45° FOV
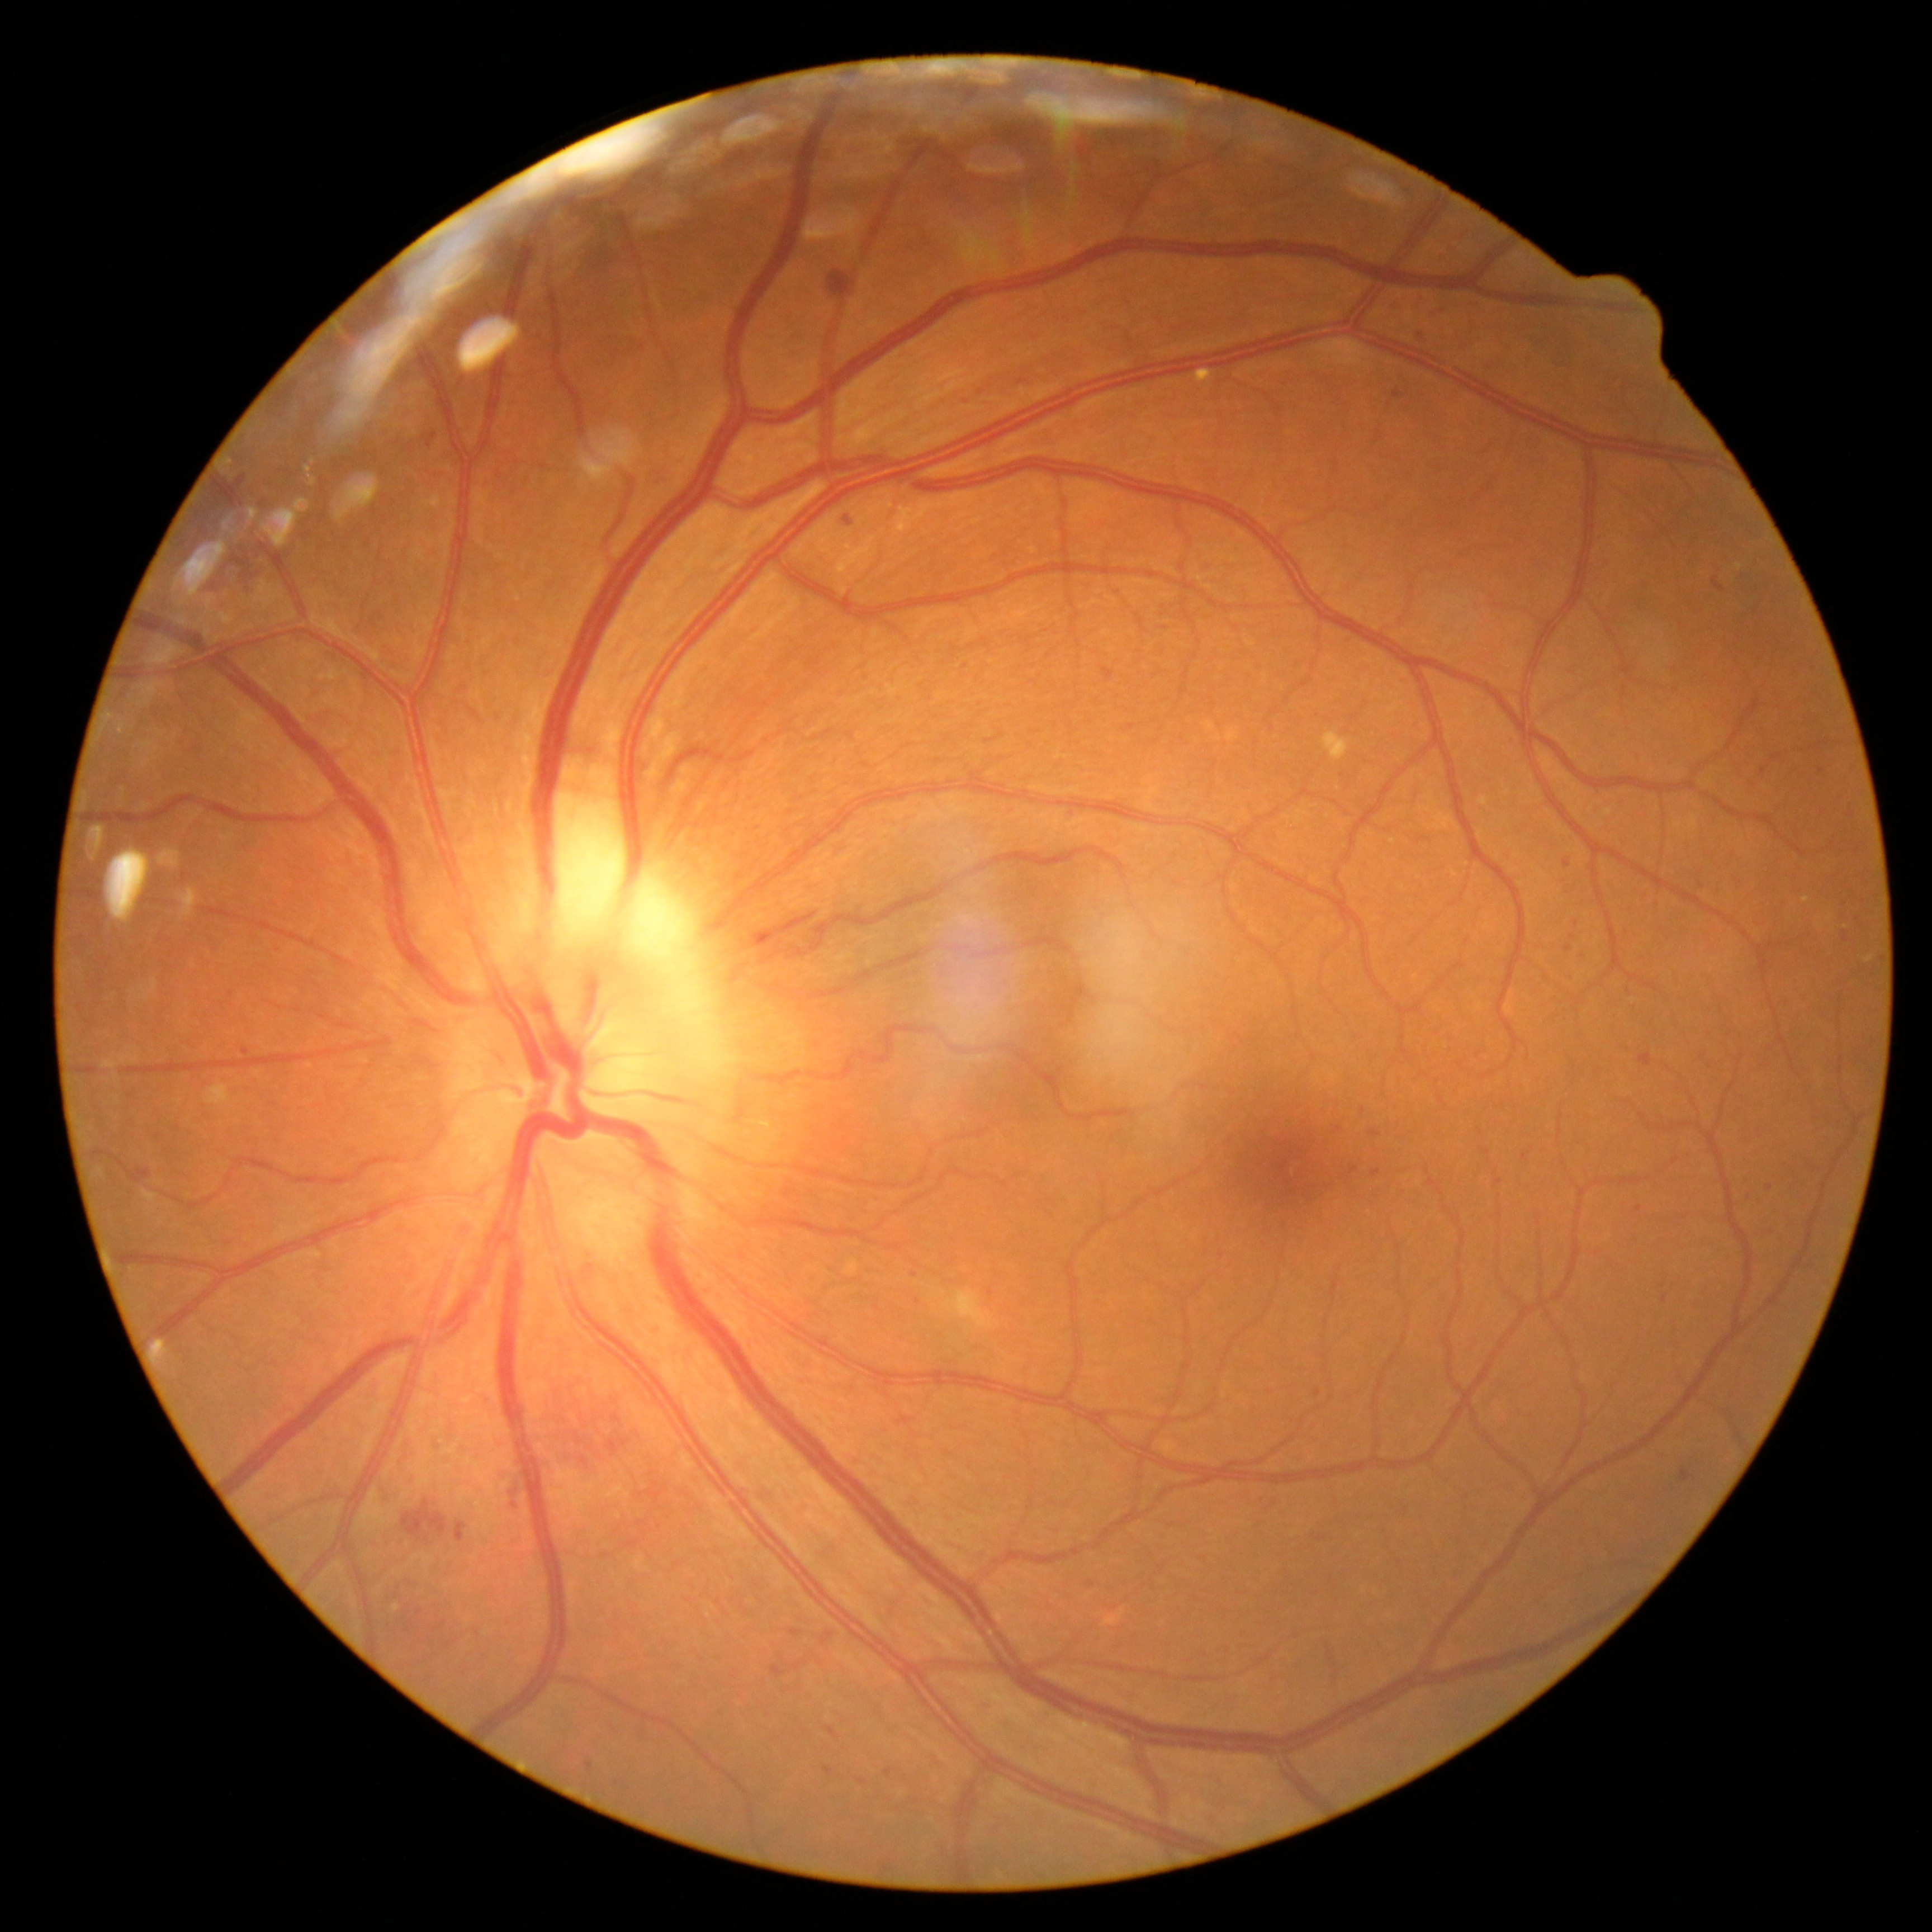
Diabetic retinopathy (DR) is grade 2
Selected lesions:
hard exudates (EXs): not present
hemorrhages (HEs): [179, 480, 285, 593]; [532, 1375, 632, 1475]; [505, 1472, 524, 1519]; [828, 270, 857, 300]; [456, 1522, 465, 1542]; [402, 1499, 447, 1545]; [1713, 579, 1723, 592]; [757, 903, 821, 942]
microaneurysms (MAs) (more not shown): [1351, 1167, 1359, 1172]; [1634, 1206, 1643, 1214]; [839, 514, 855, 533]; [1640, 1054, 1653, 1066]; [1371, 1170, 1380, 1178]; [857, 1776, 868, 1785]; [1416, 333, 1424, 340]; [790, 1628, 803, 1637]; [1566, 944, 1573, 953]; [976, 385, 983, 395]; [138, 1169, 150, 1185]; [1103, 667, 1114, 679]
Smaller MAs around 918:1301; 1770:1187; 915:1274; 1573:937; 158:1137; 1364:1111; 877:1308; 245:1051
soft exudates (SEs): [967, 1324, 973, 1332]; [925, 1284, 946, 1300]; [940, 1289, 1001, 1330]